2212x1659 — 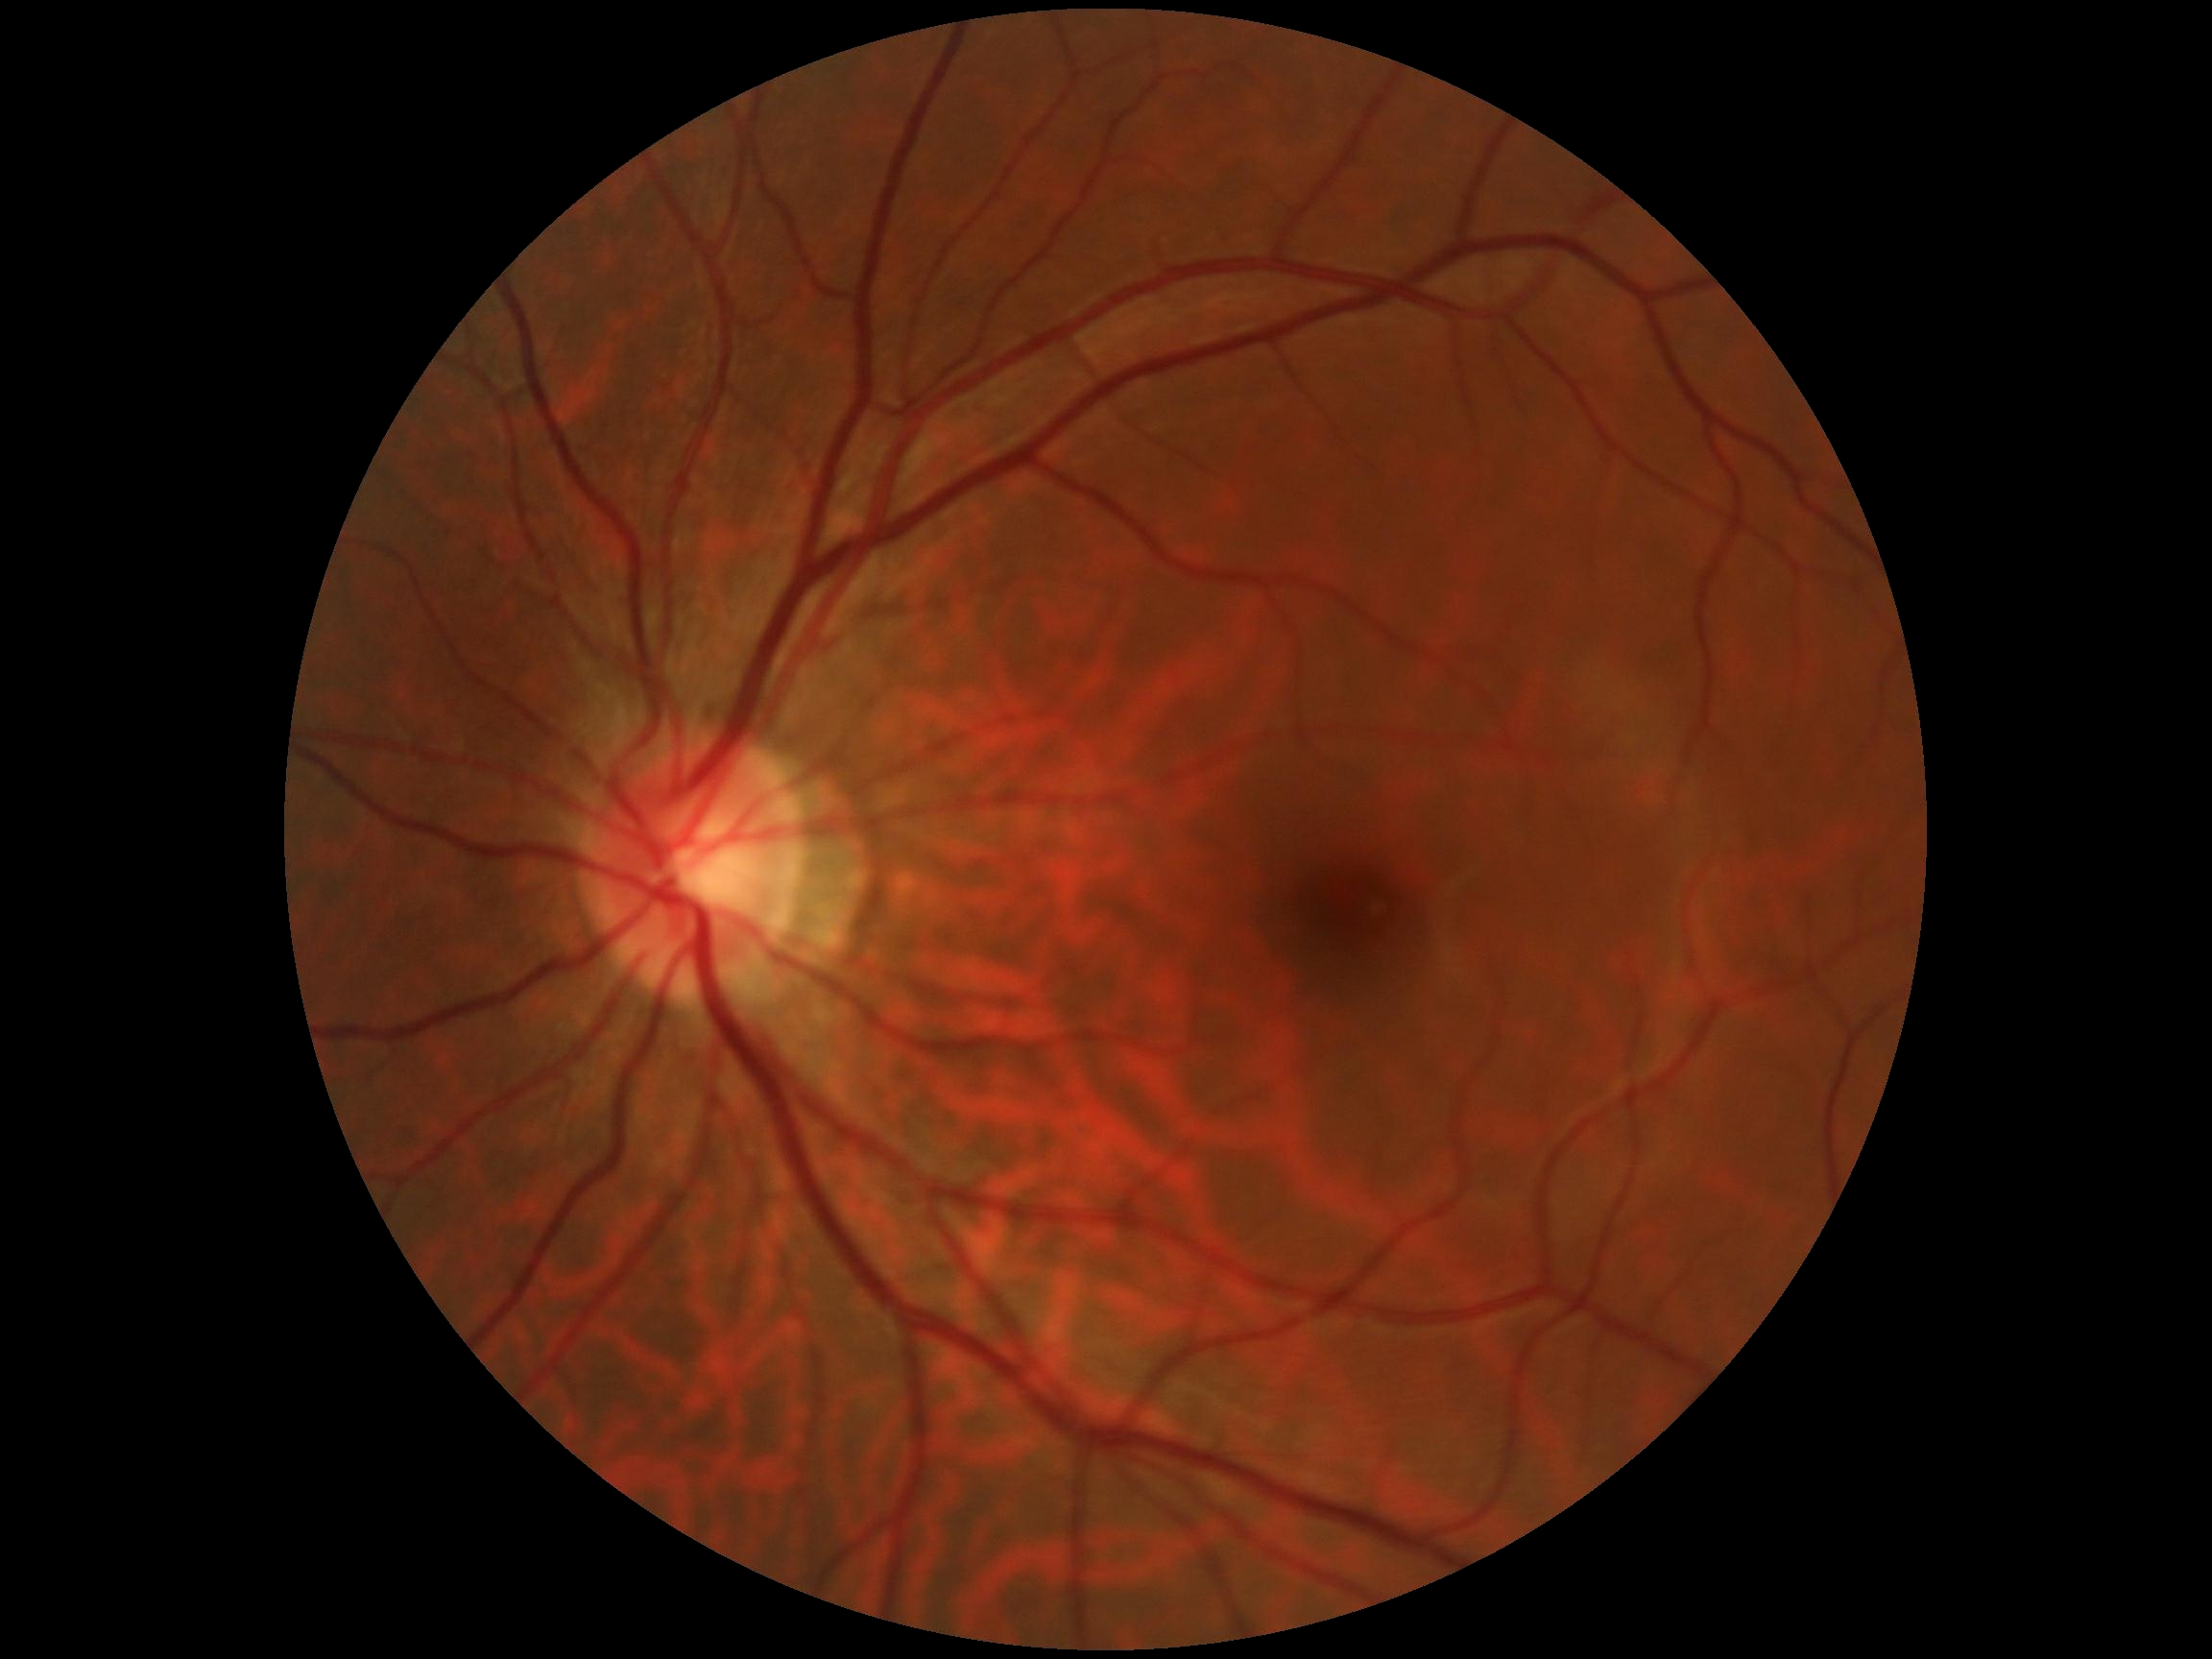 diabetic retinopathy severity=grade 0.